Retinal fundus photograph · 69-year-old patient · refractive error: +1.5 -7.5 × 95° · FOV: 30 degrees.
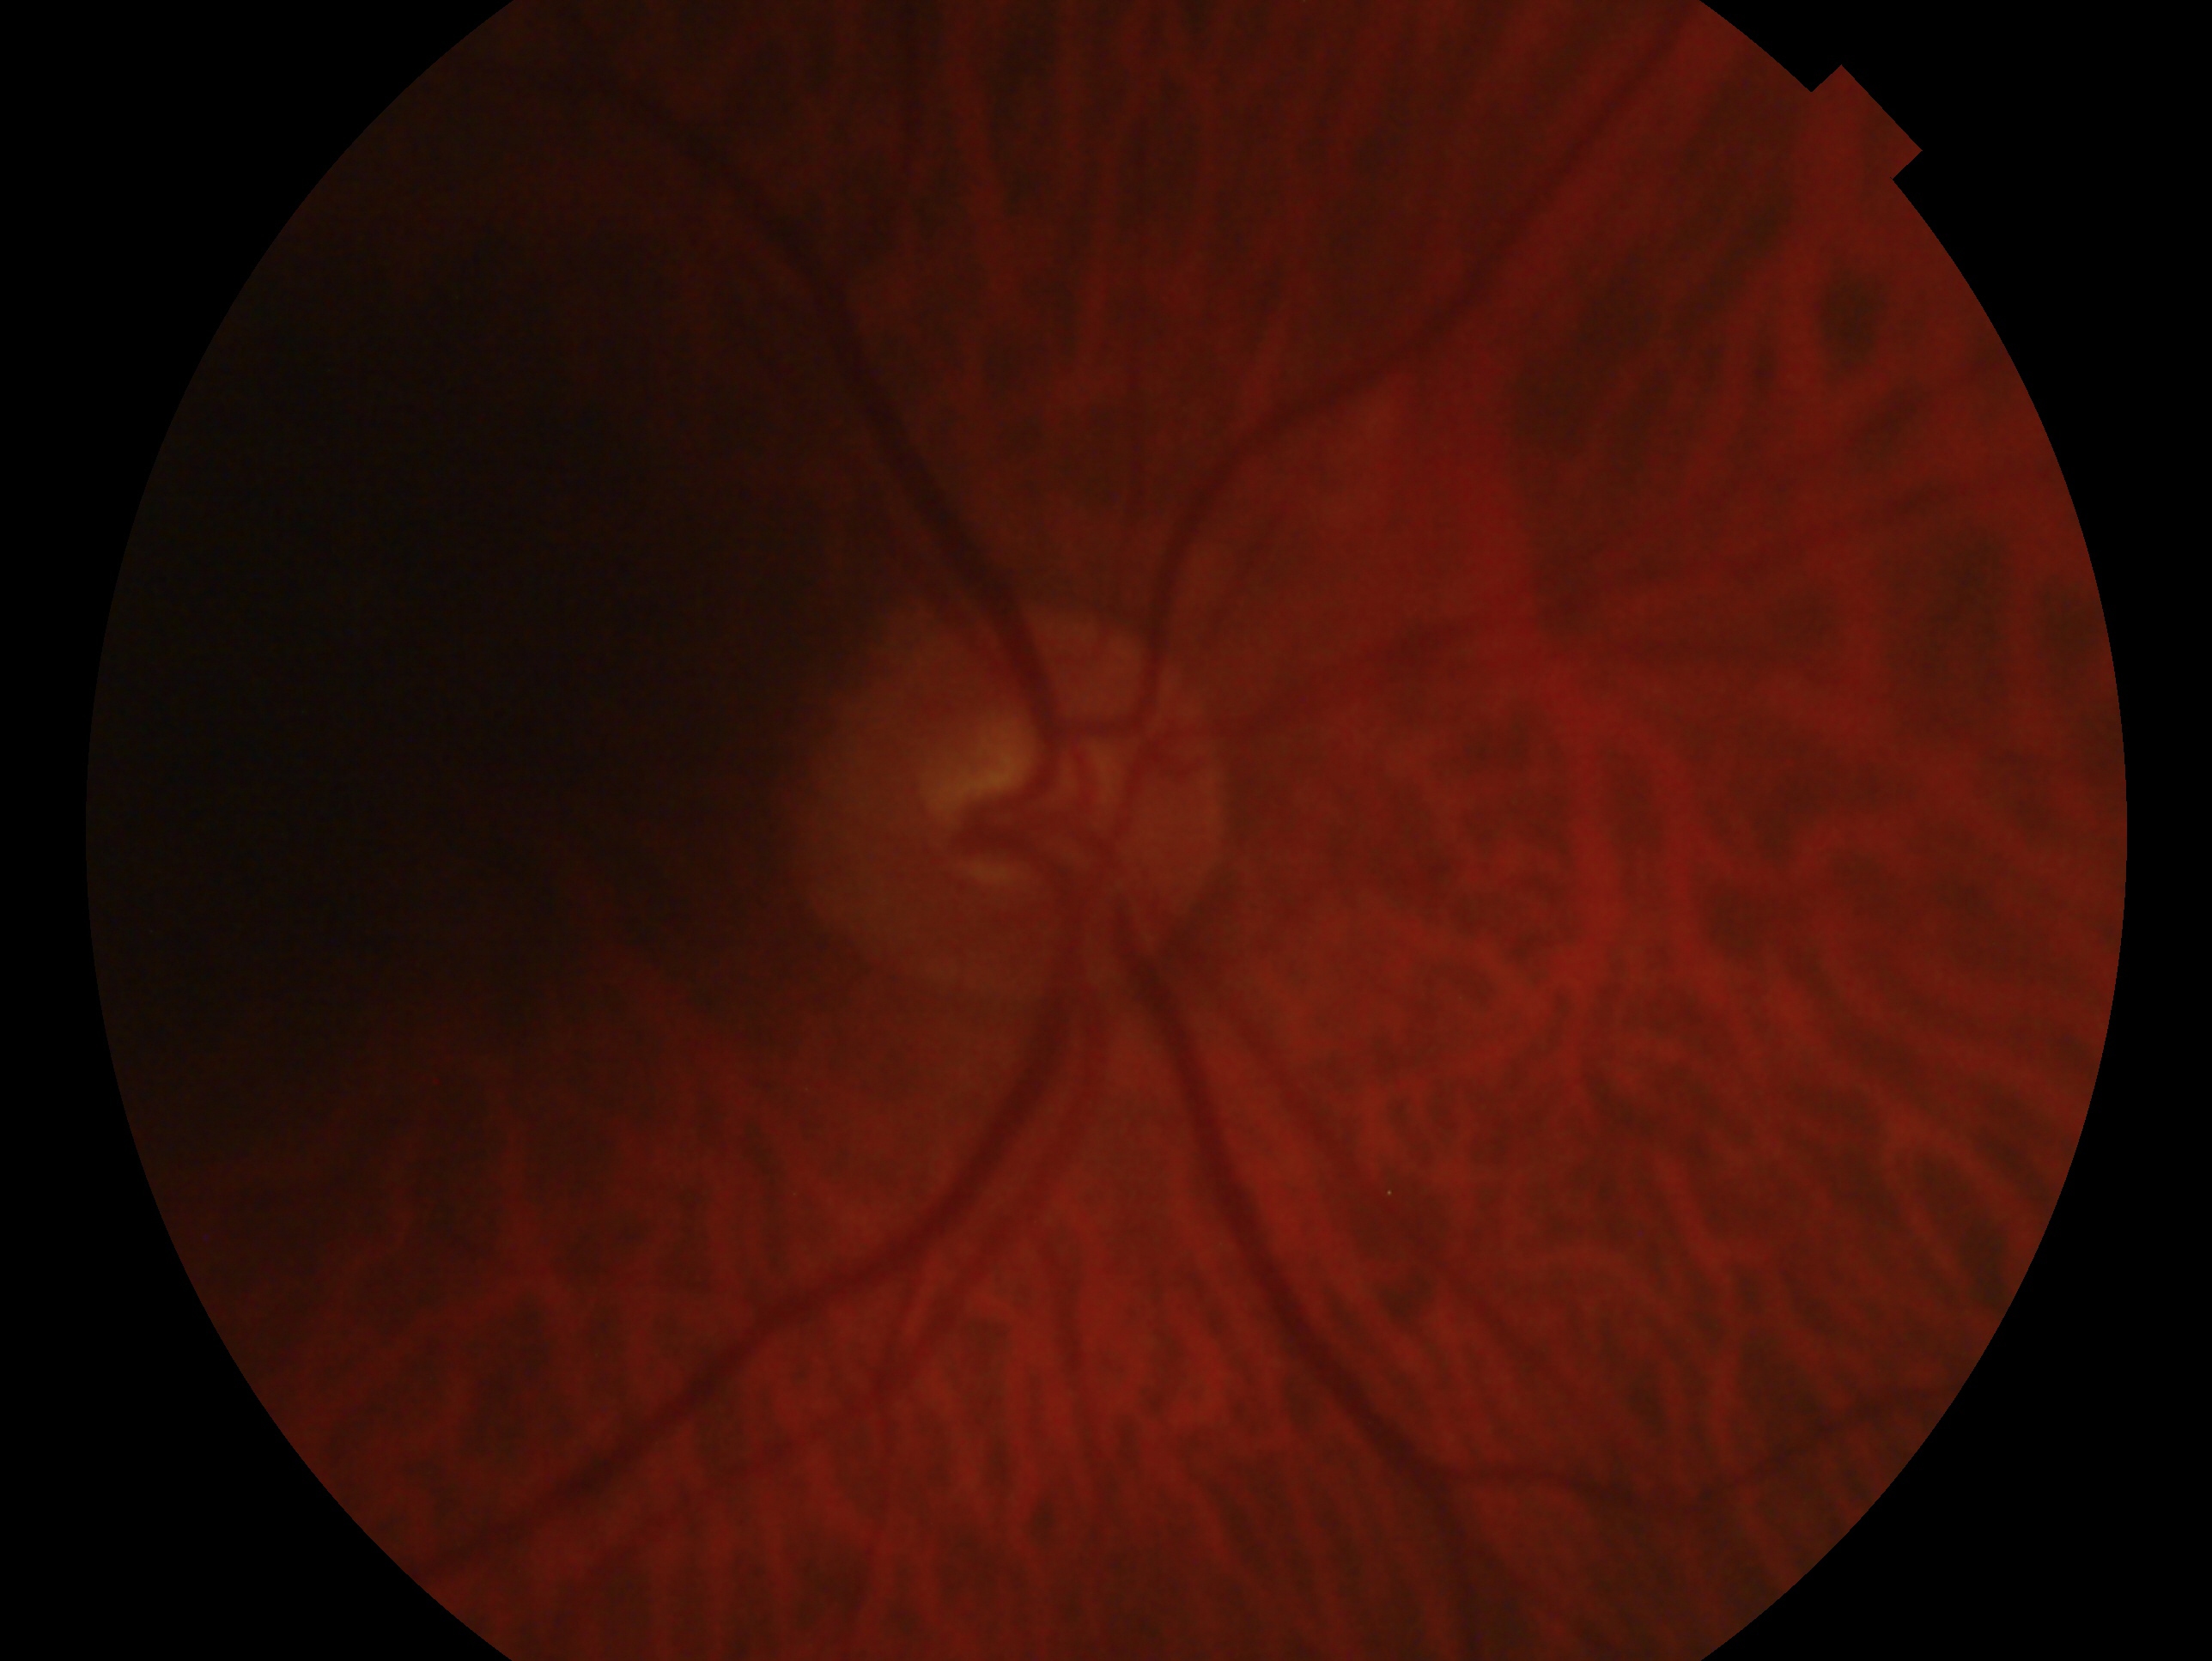

{
  "eye": "OD",
  "glaucoma_dx": "no evidence of glaucoma"
}